Nonmydriatic fundus photograph · NIDEK AFC-230:
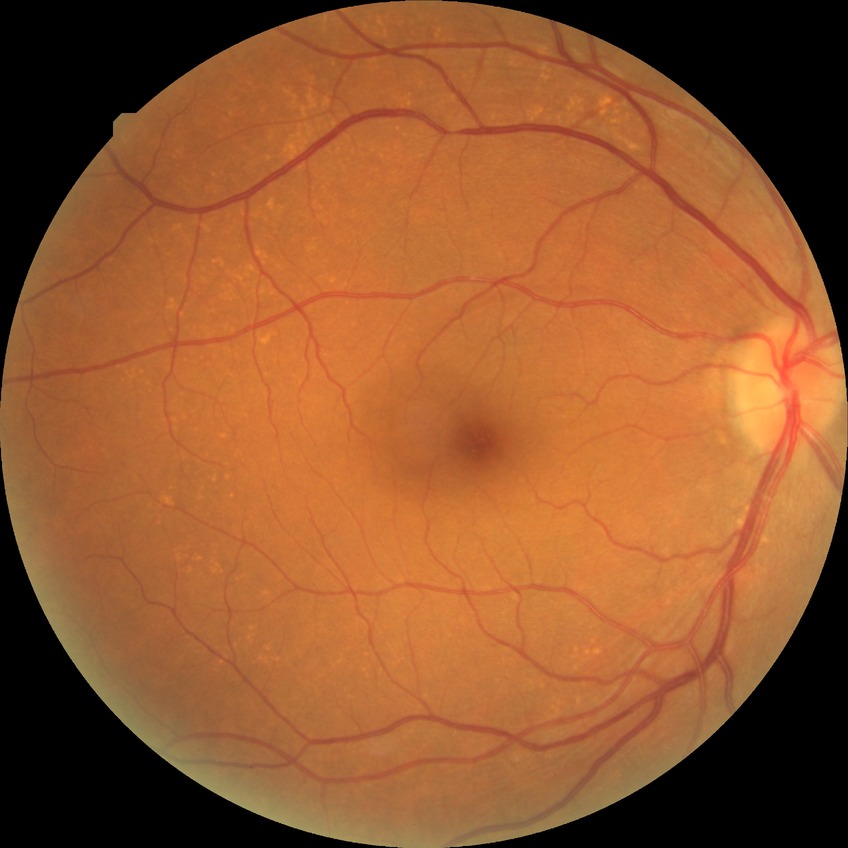
Diabetic retinopathy severity is no diabetic retinopathy.